Diabetic retinopathy graded by the modified Davis classification; fundus photo; 45 degree fundus photograph.
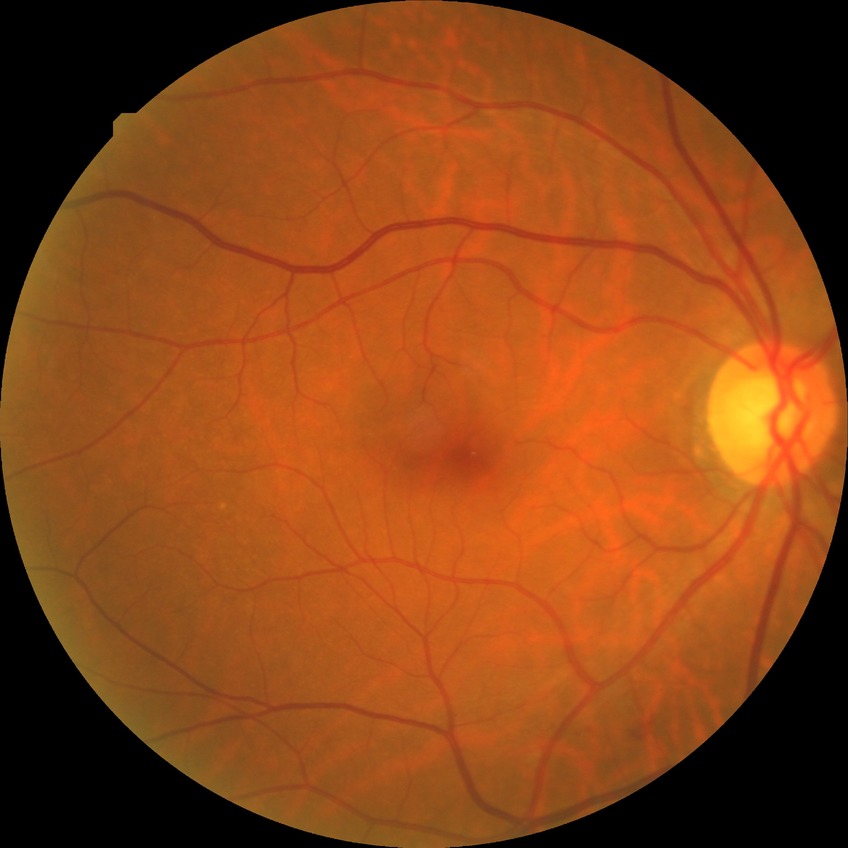

– DR class: non-proliferative diabetic retinopathy
– Davis DR grade: SDR